Retinal fundus photograph
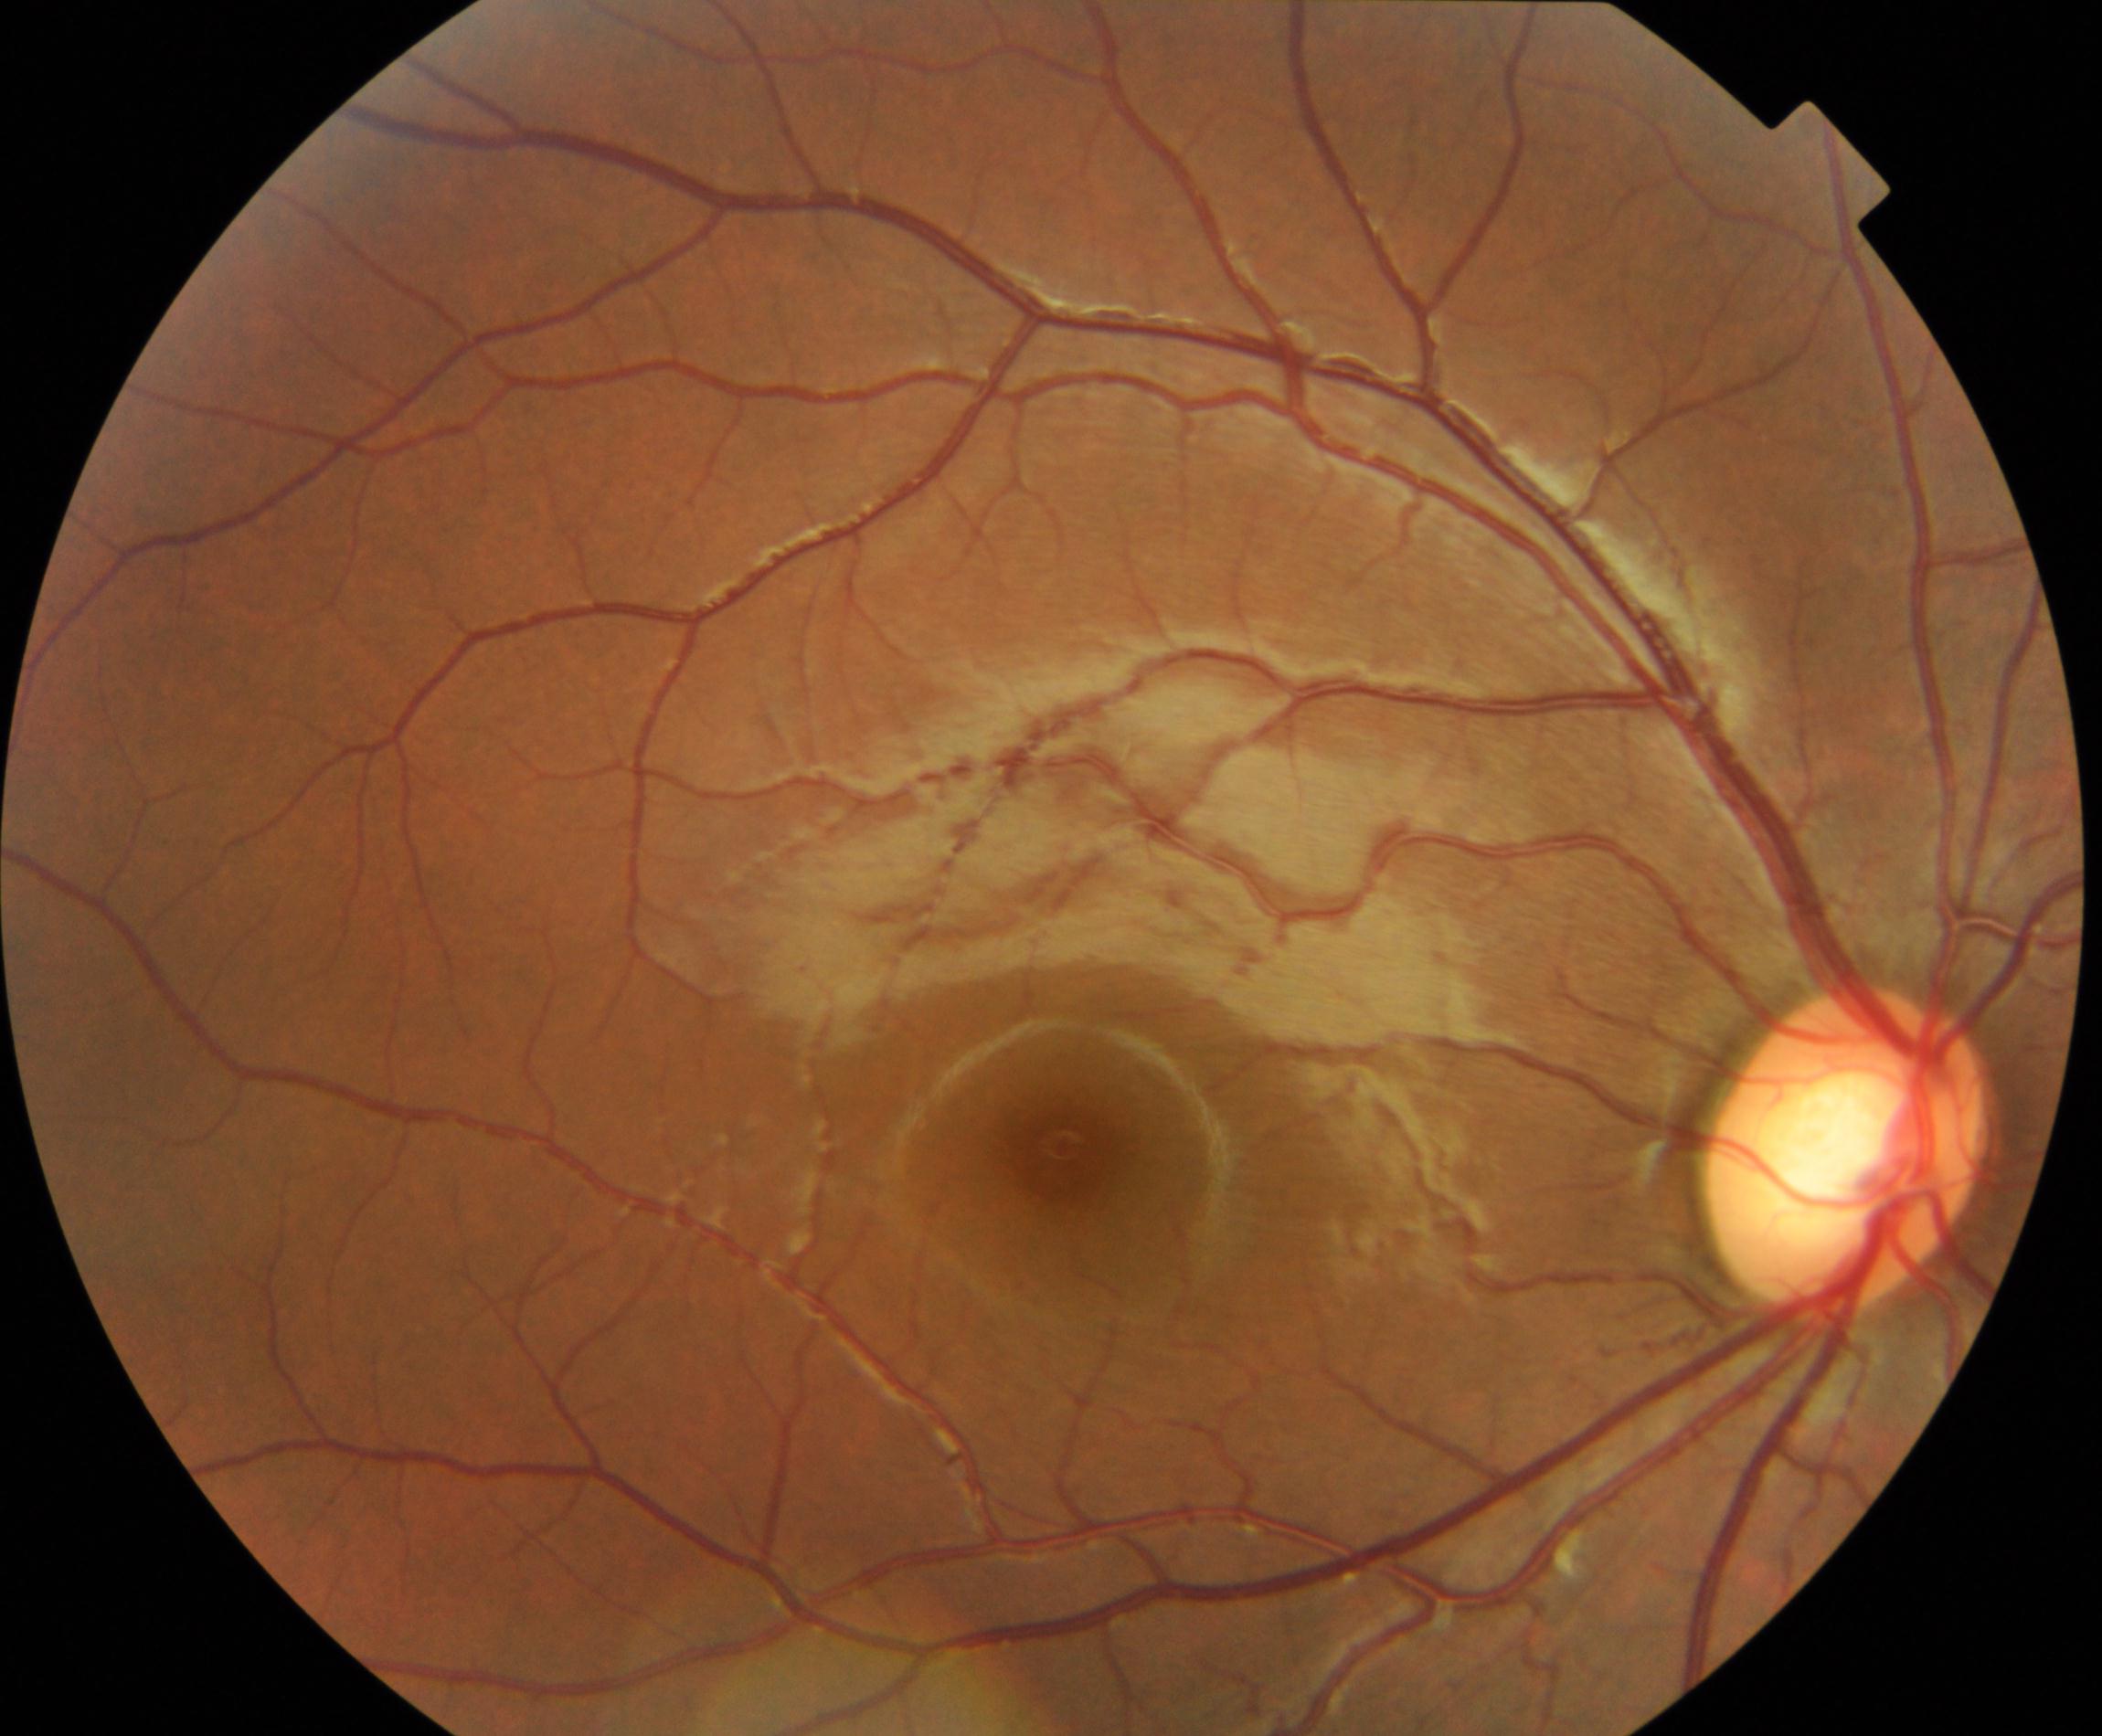
Findings consistent with large optic cup. Features include cup-to-disc ratio greater than 0.5, with a pink neuroretinal rim following the ISNT rule, without notching or bayoneting of vessels.